Modified Davis classification; 848x848; nonmydriatic — 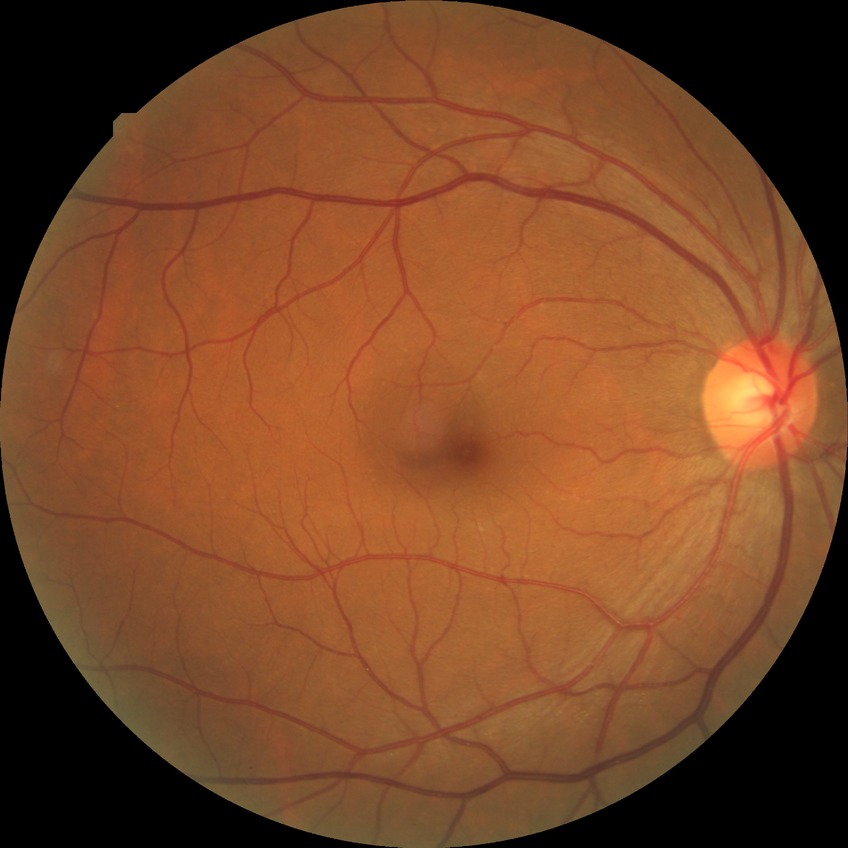
Retinopathy grade: no diabetic retinopathy.